640 x 480 pixels; pediatric wide-field fundus photograph — 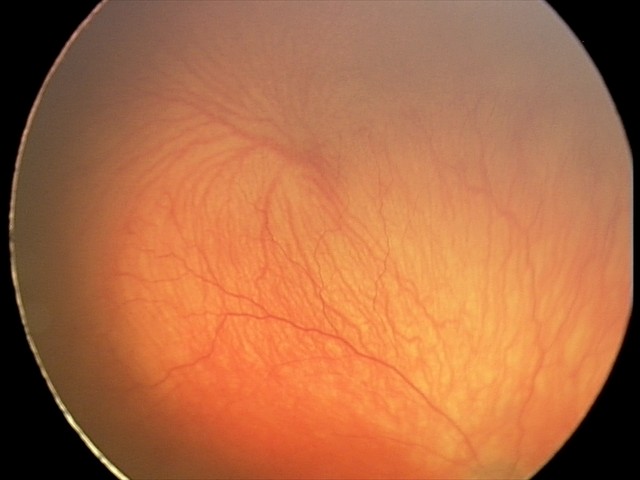 Q: What is the plus-form classification?
A: plus disease — abnormal dilation and tortuosity of the posterior pole retinal vessels
Q: What is the diagnosis from this examination?
A: aggressive ROP (A-ROP) — rapidly progressive severe ROP with prominent plus disease, often without classic stage progression